2352 x 1568 pixels, FOV: 45 degrees — 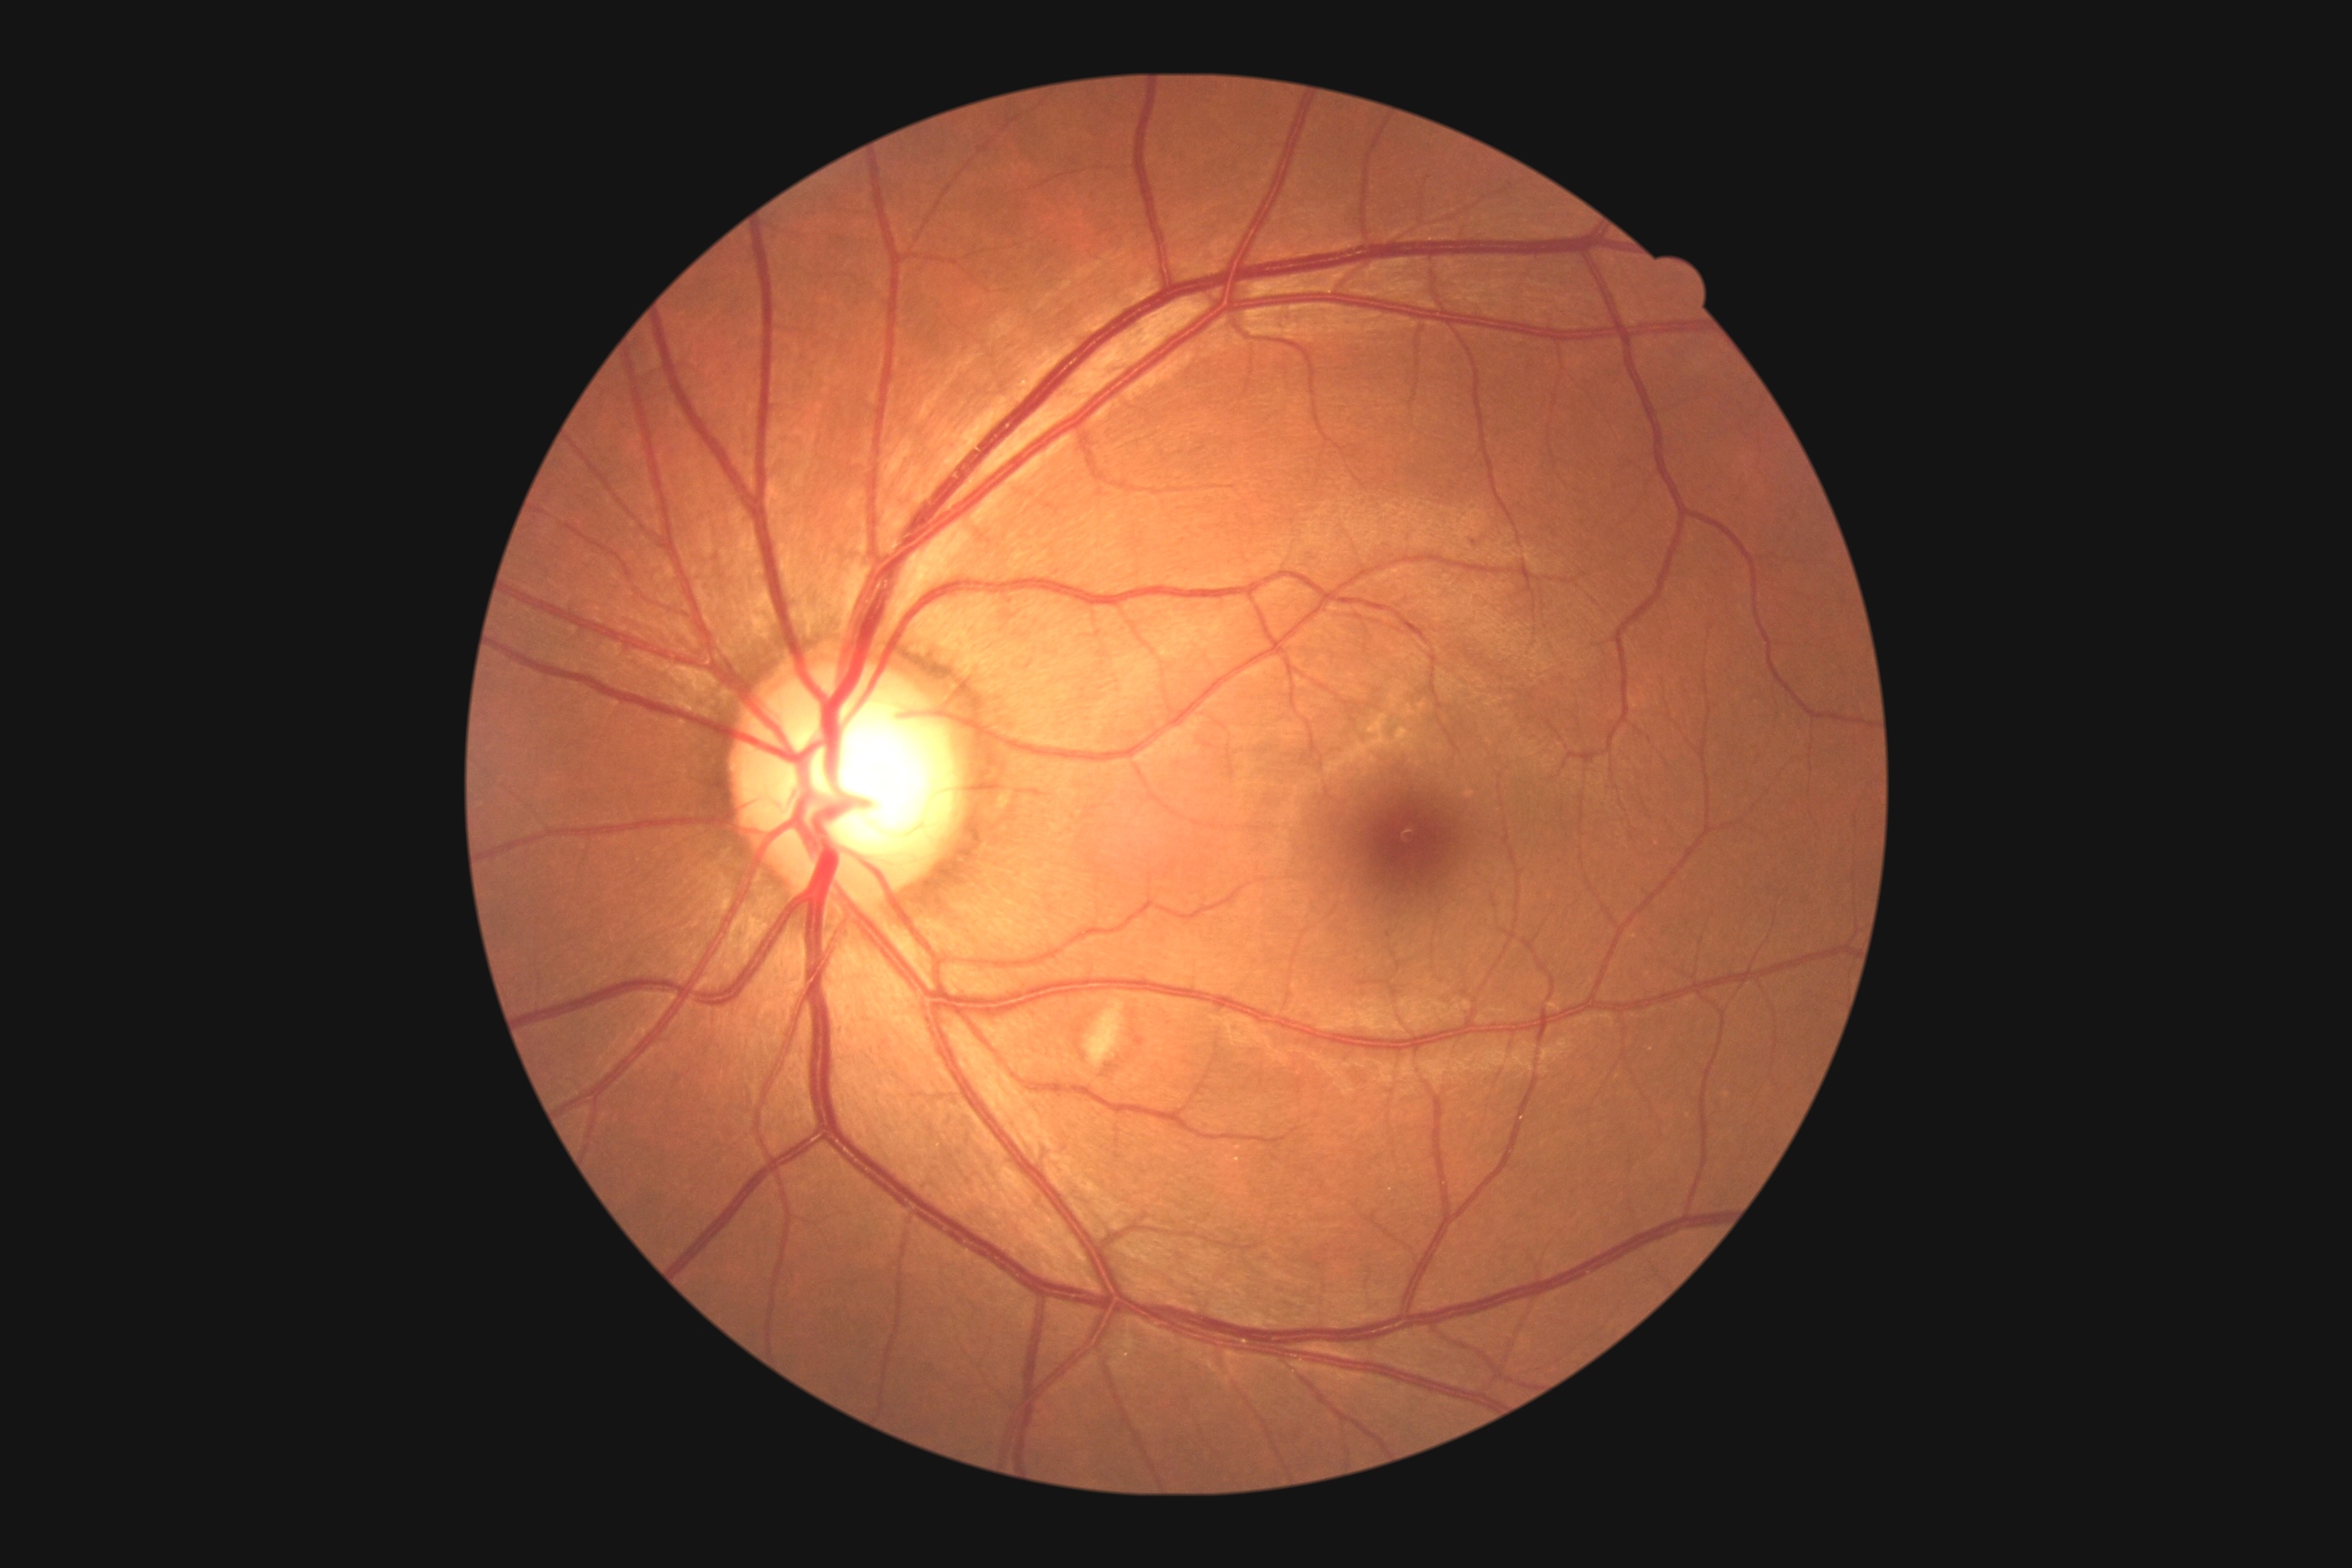
Retinopathy: moderate NPDR (grade 2) — more than just microaneurysms but less than severe NPDR.